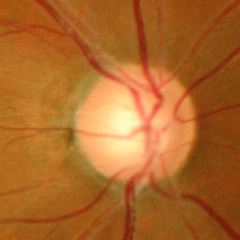

Advanced-stage glaucoma.